50° field of view. Fundus photo: 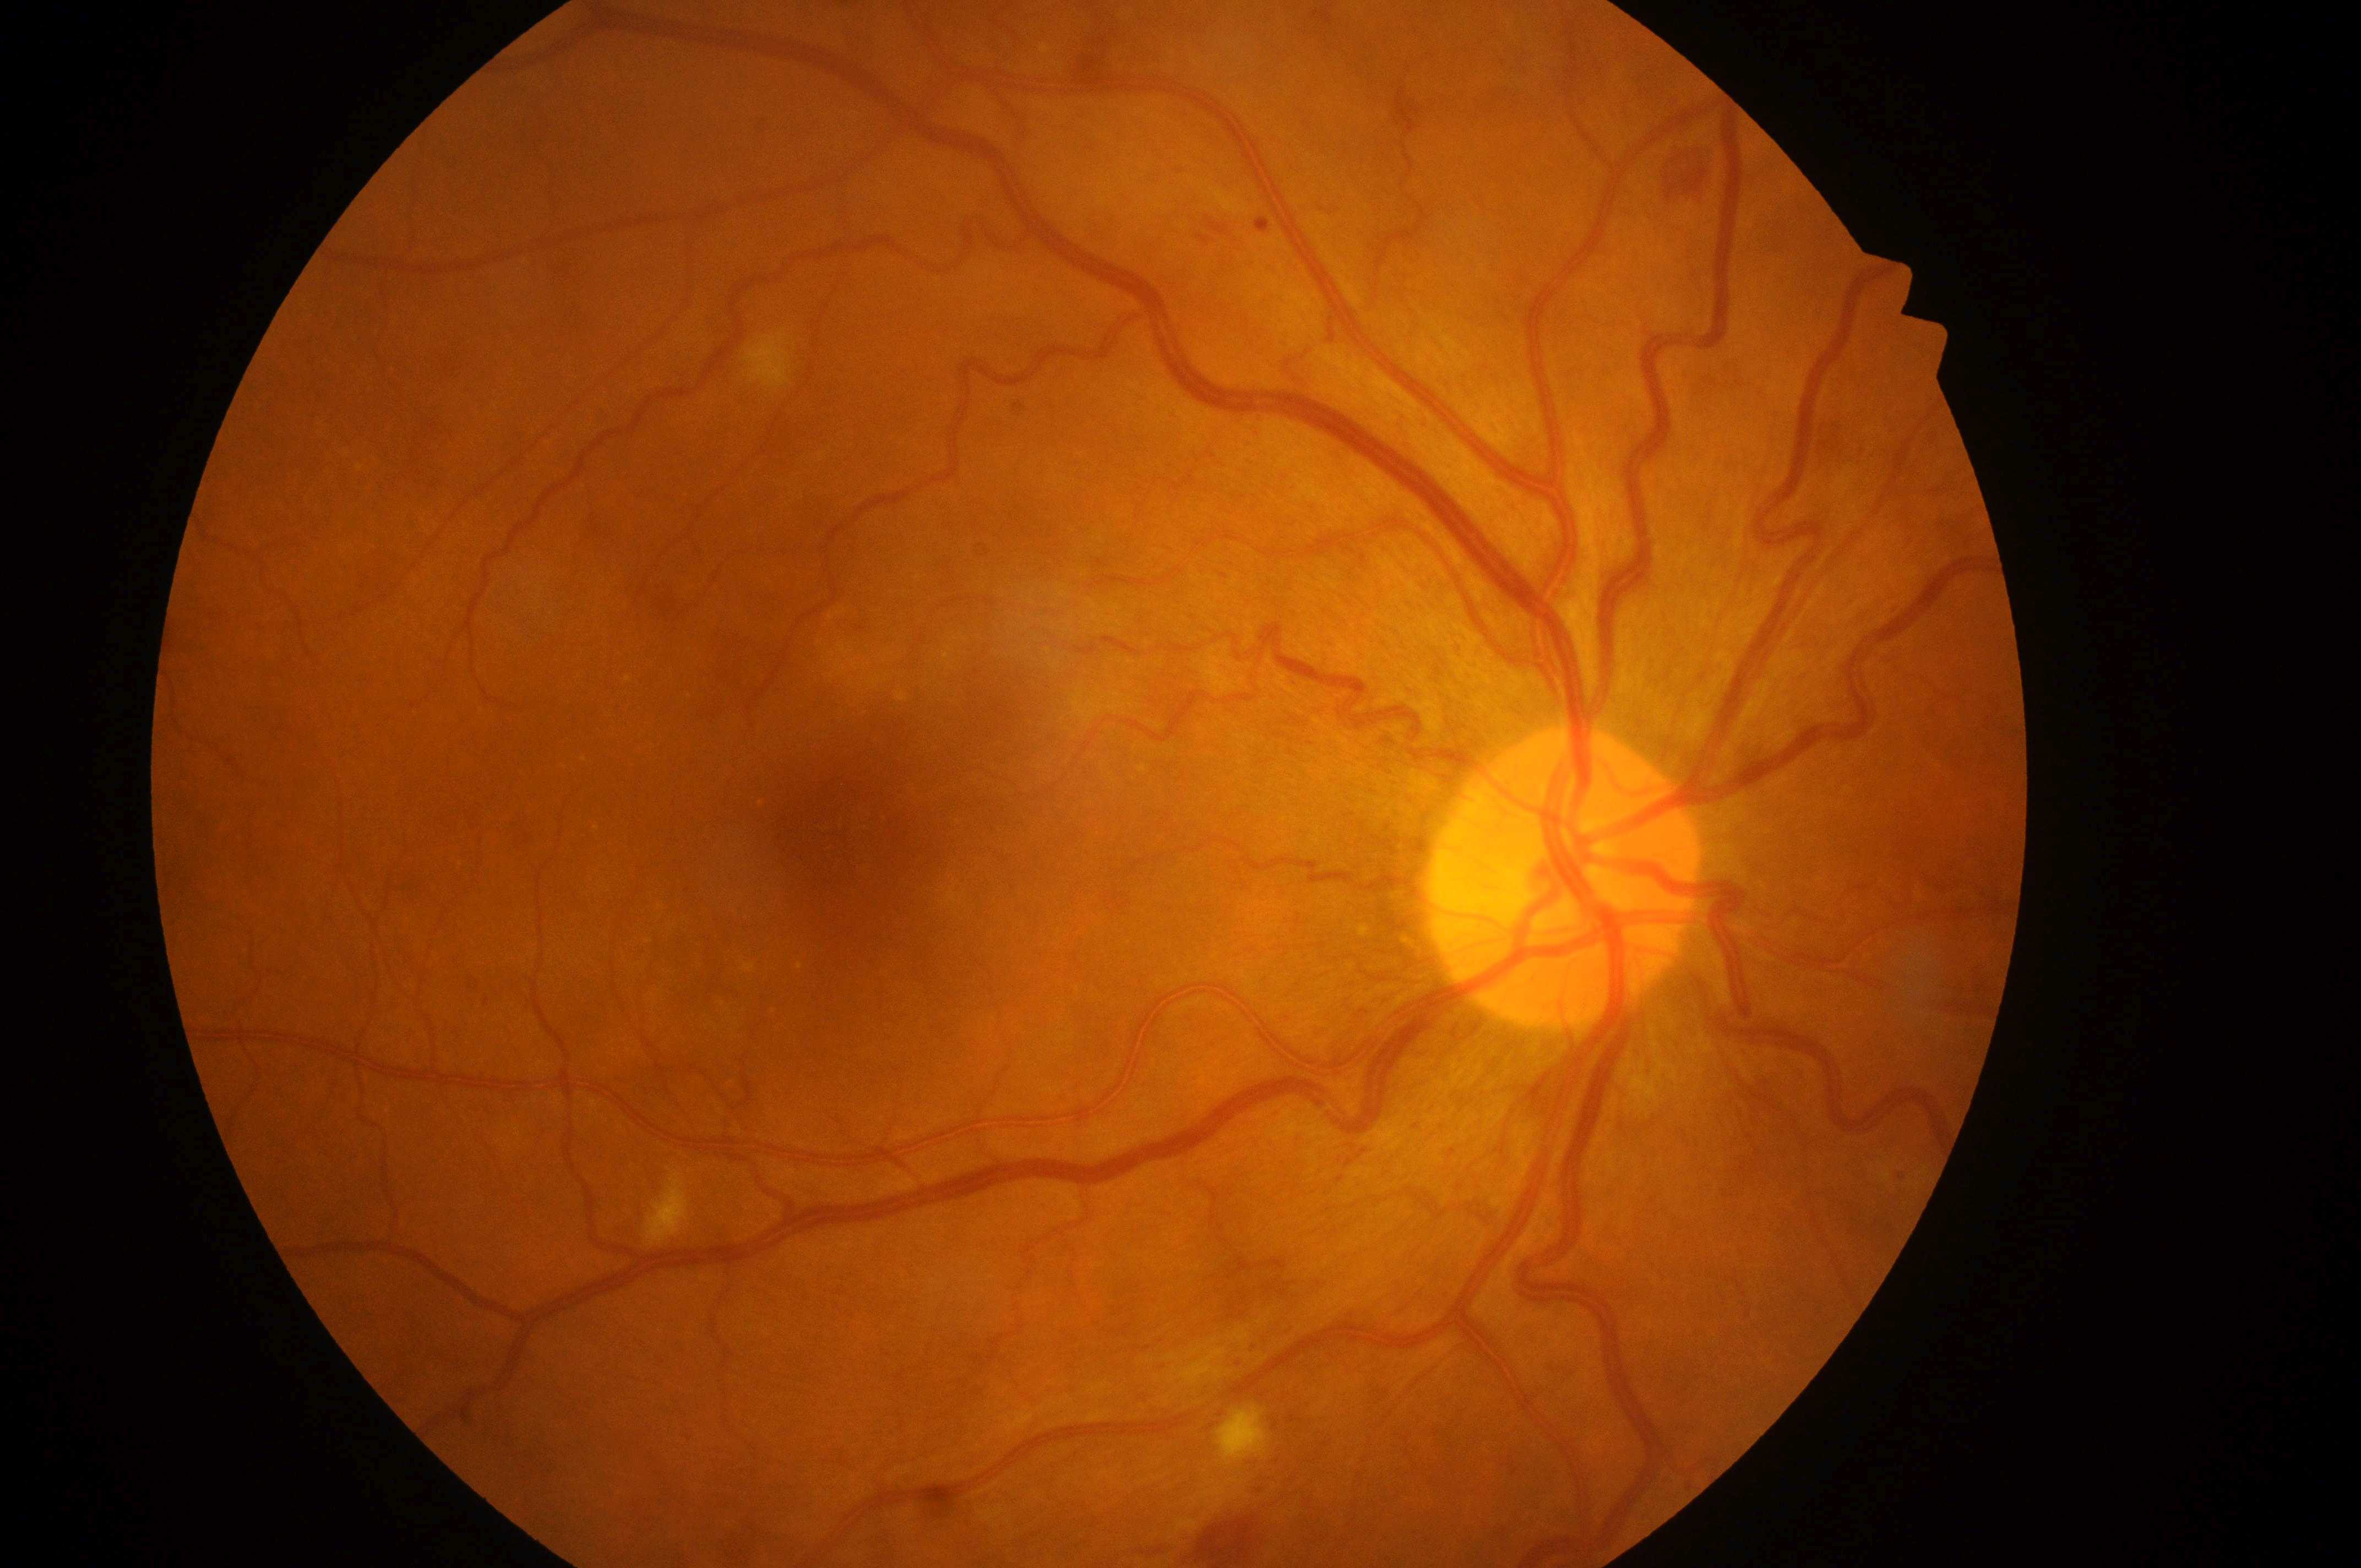 DR severity = moderate non-proliferative diabetic retinopathy (grade 2) | ONH = (x=1564, y=890) | laterality = right | fovea centralis = (x=833, y=837) | DME = no risk (grade 0).